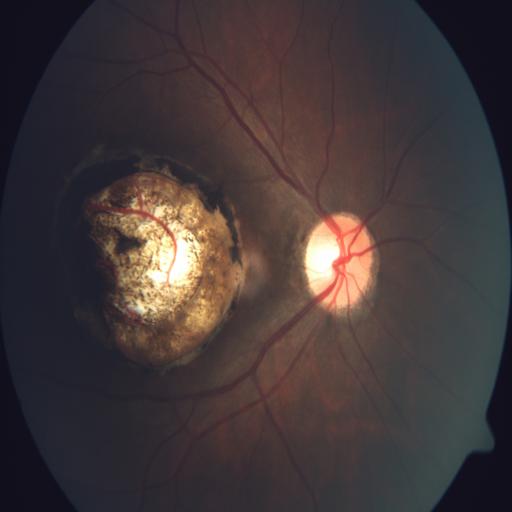
Impression: coloboma.